45 degree fundus photograph:
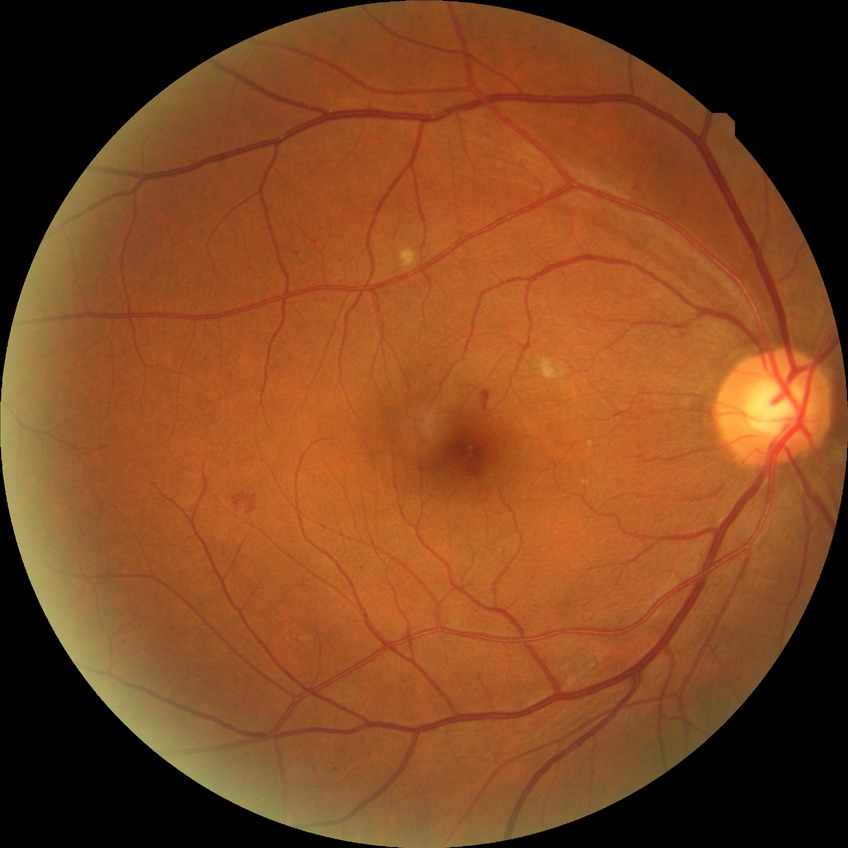
Diabetic retinopathy stage is simple diabetic retinopathy.